Fundus photo; 240x240 — 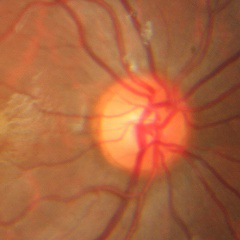

Showing no signs of glaucoma.